Wide-field fundus photograph from neonatal ROP screening.
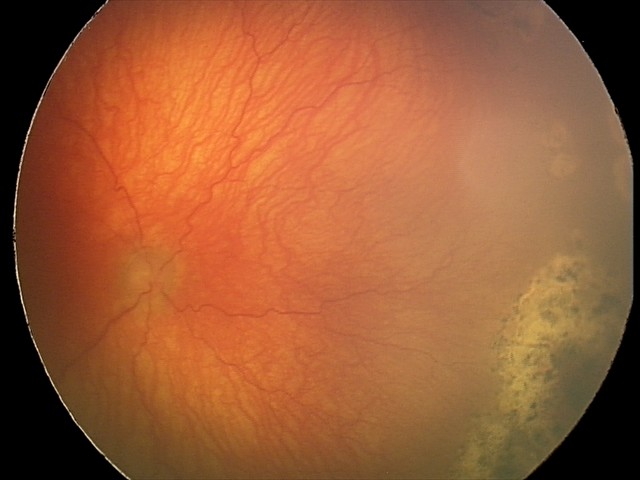
Screening diagnosis: plus disease; aggressive retinopathy of prematurity.